Fundus photo, 1725x1721px
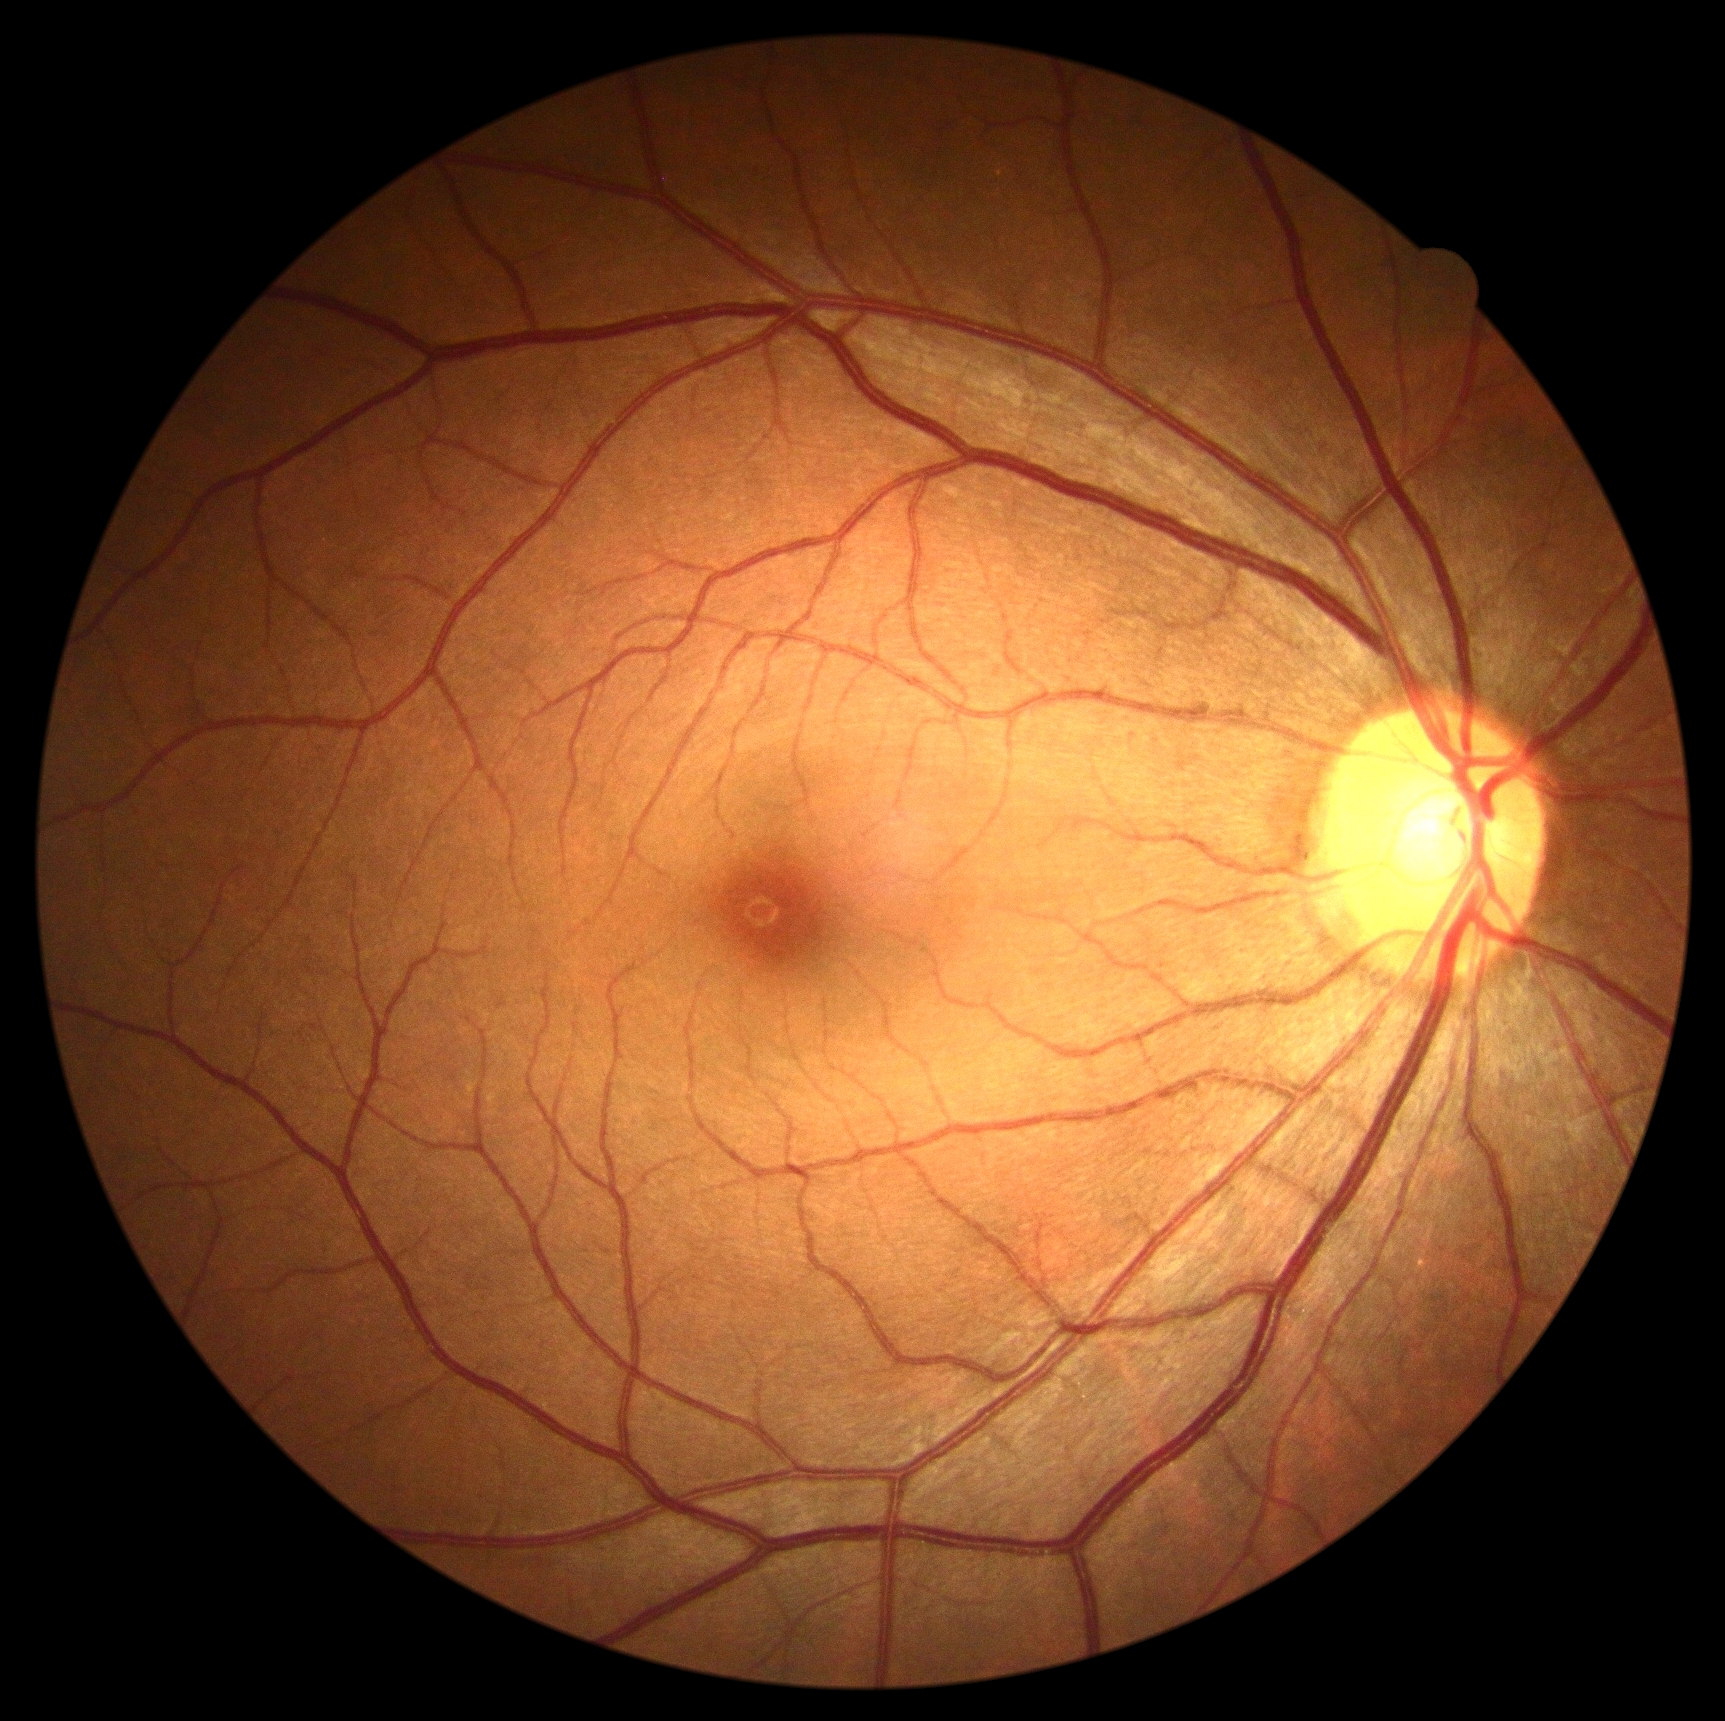

Annotations:
• diabetic retinopathy — grade 0